Image size 2048x1536, color fundus photograph, FOV: 45 degrees
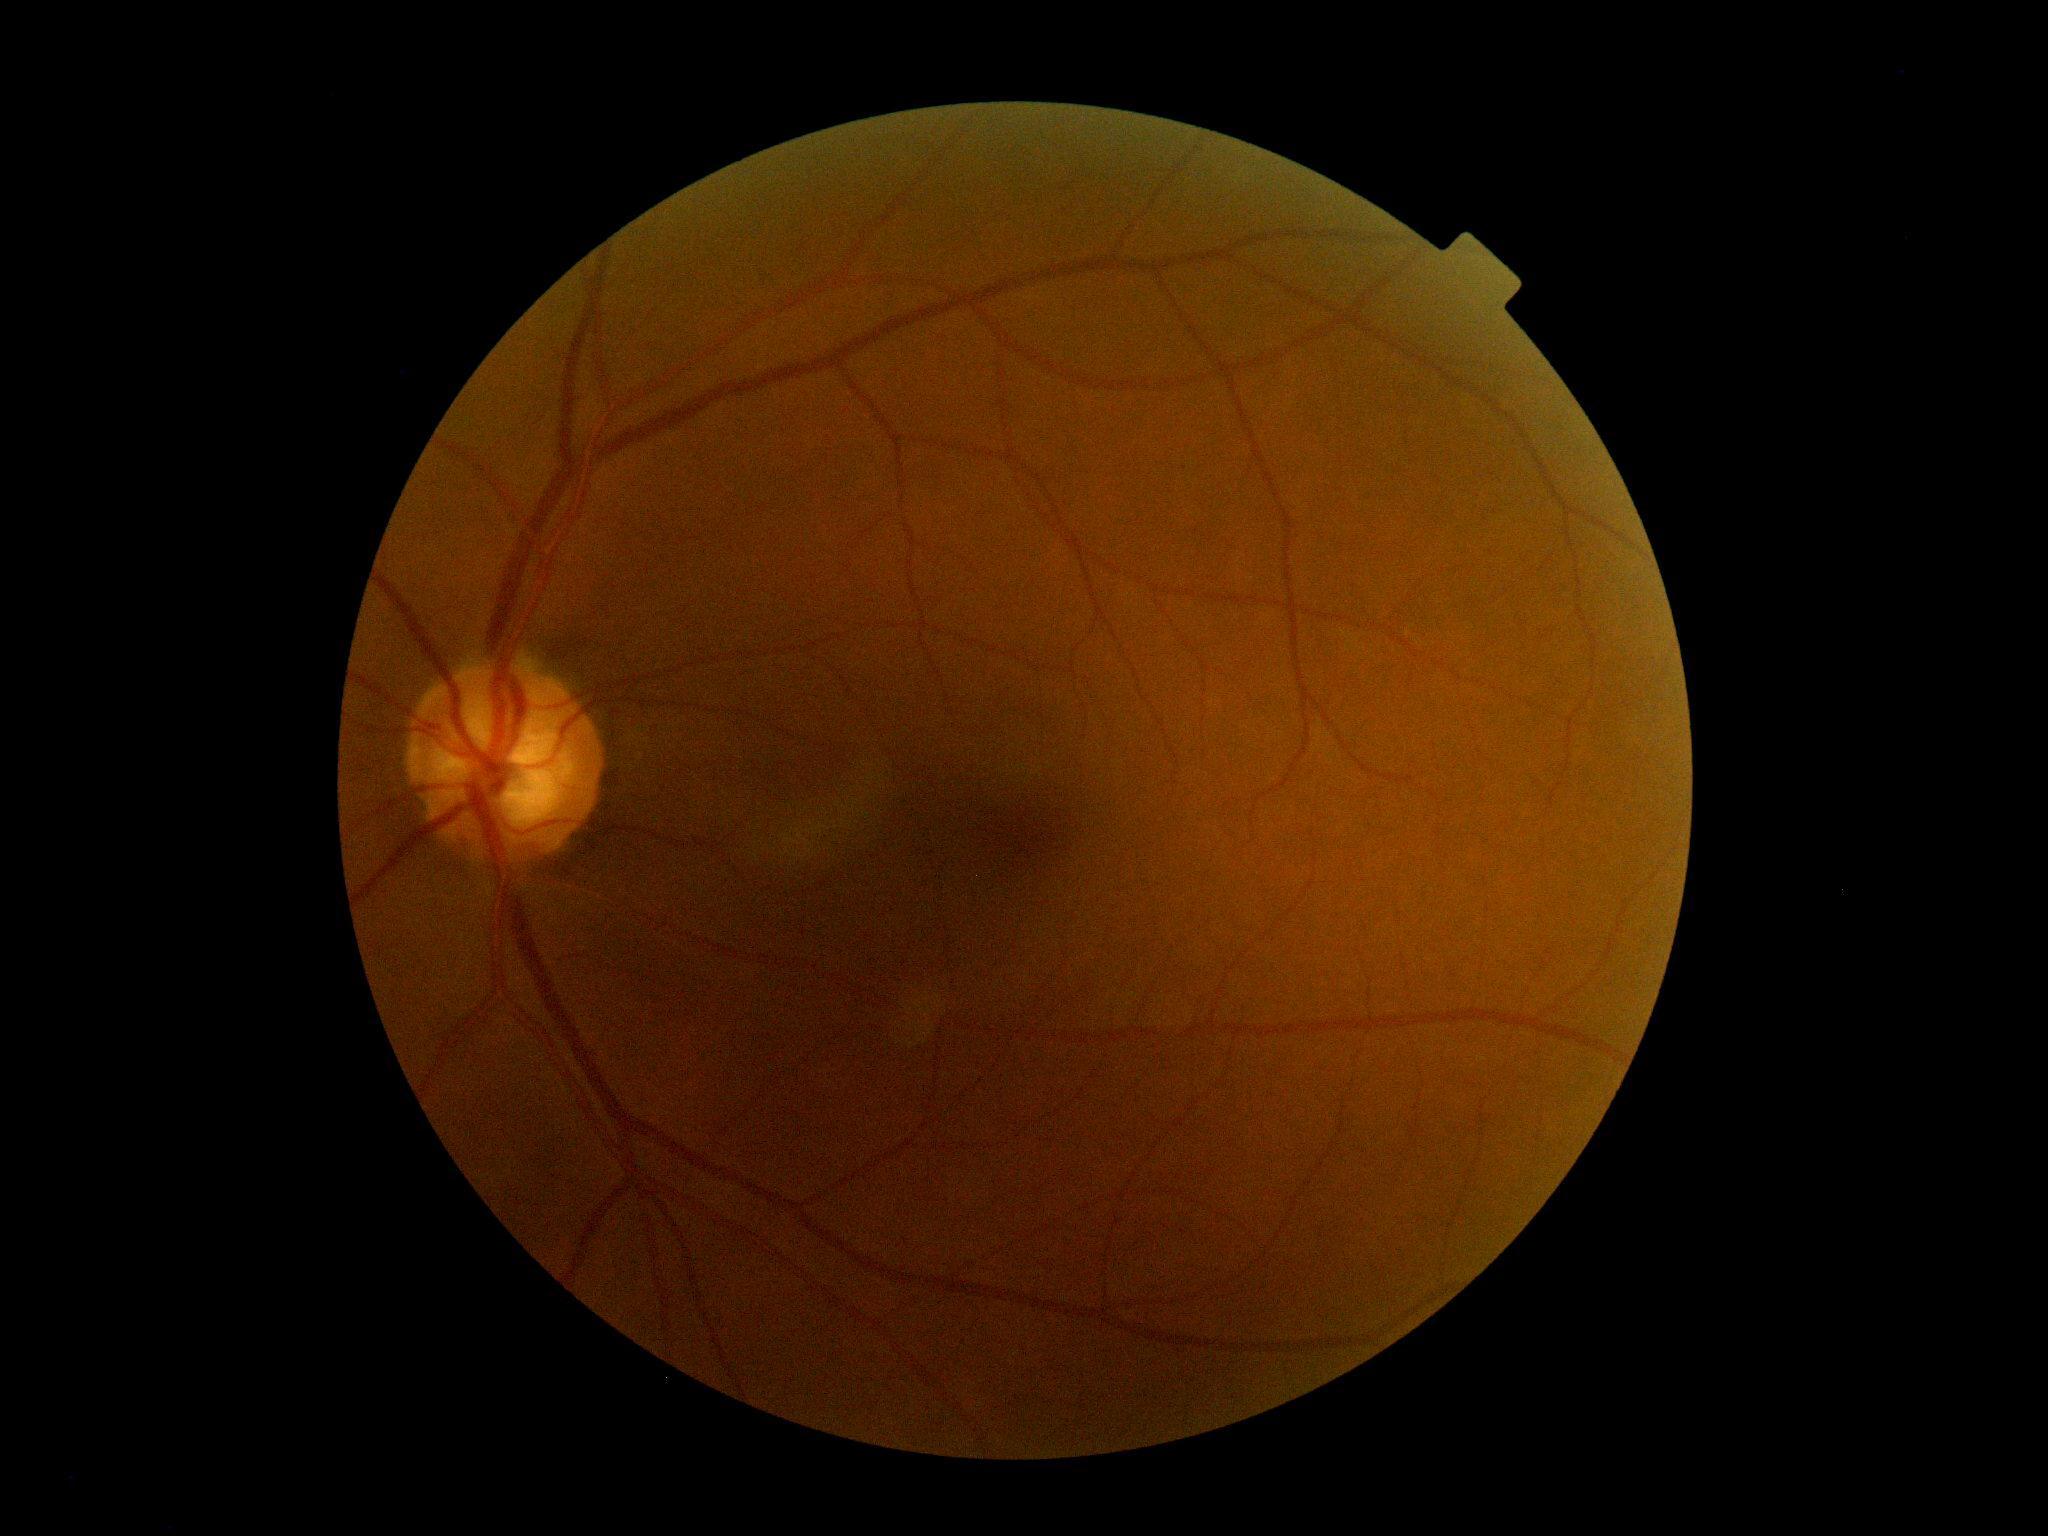

DR stage = no apparent diabetic retinopathy (grade 0); DR impression = negative for DR.